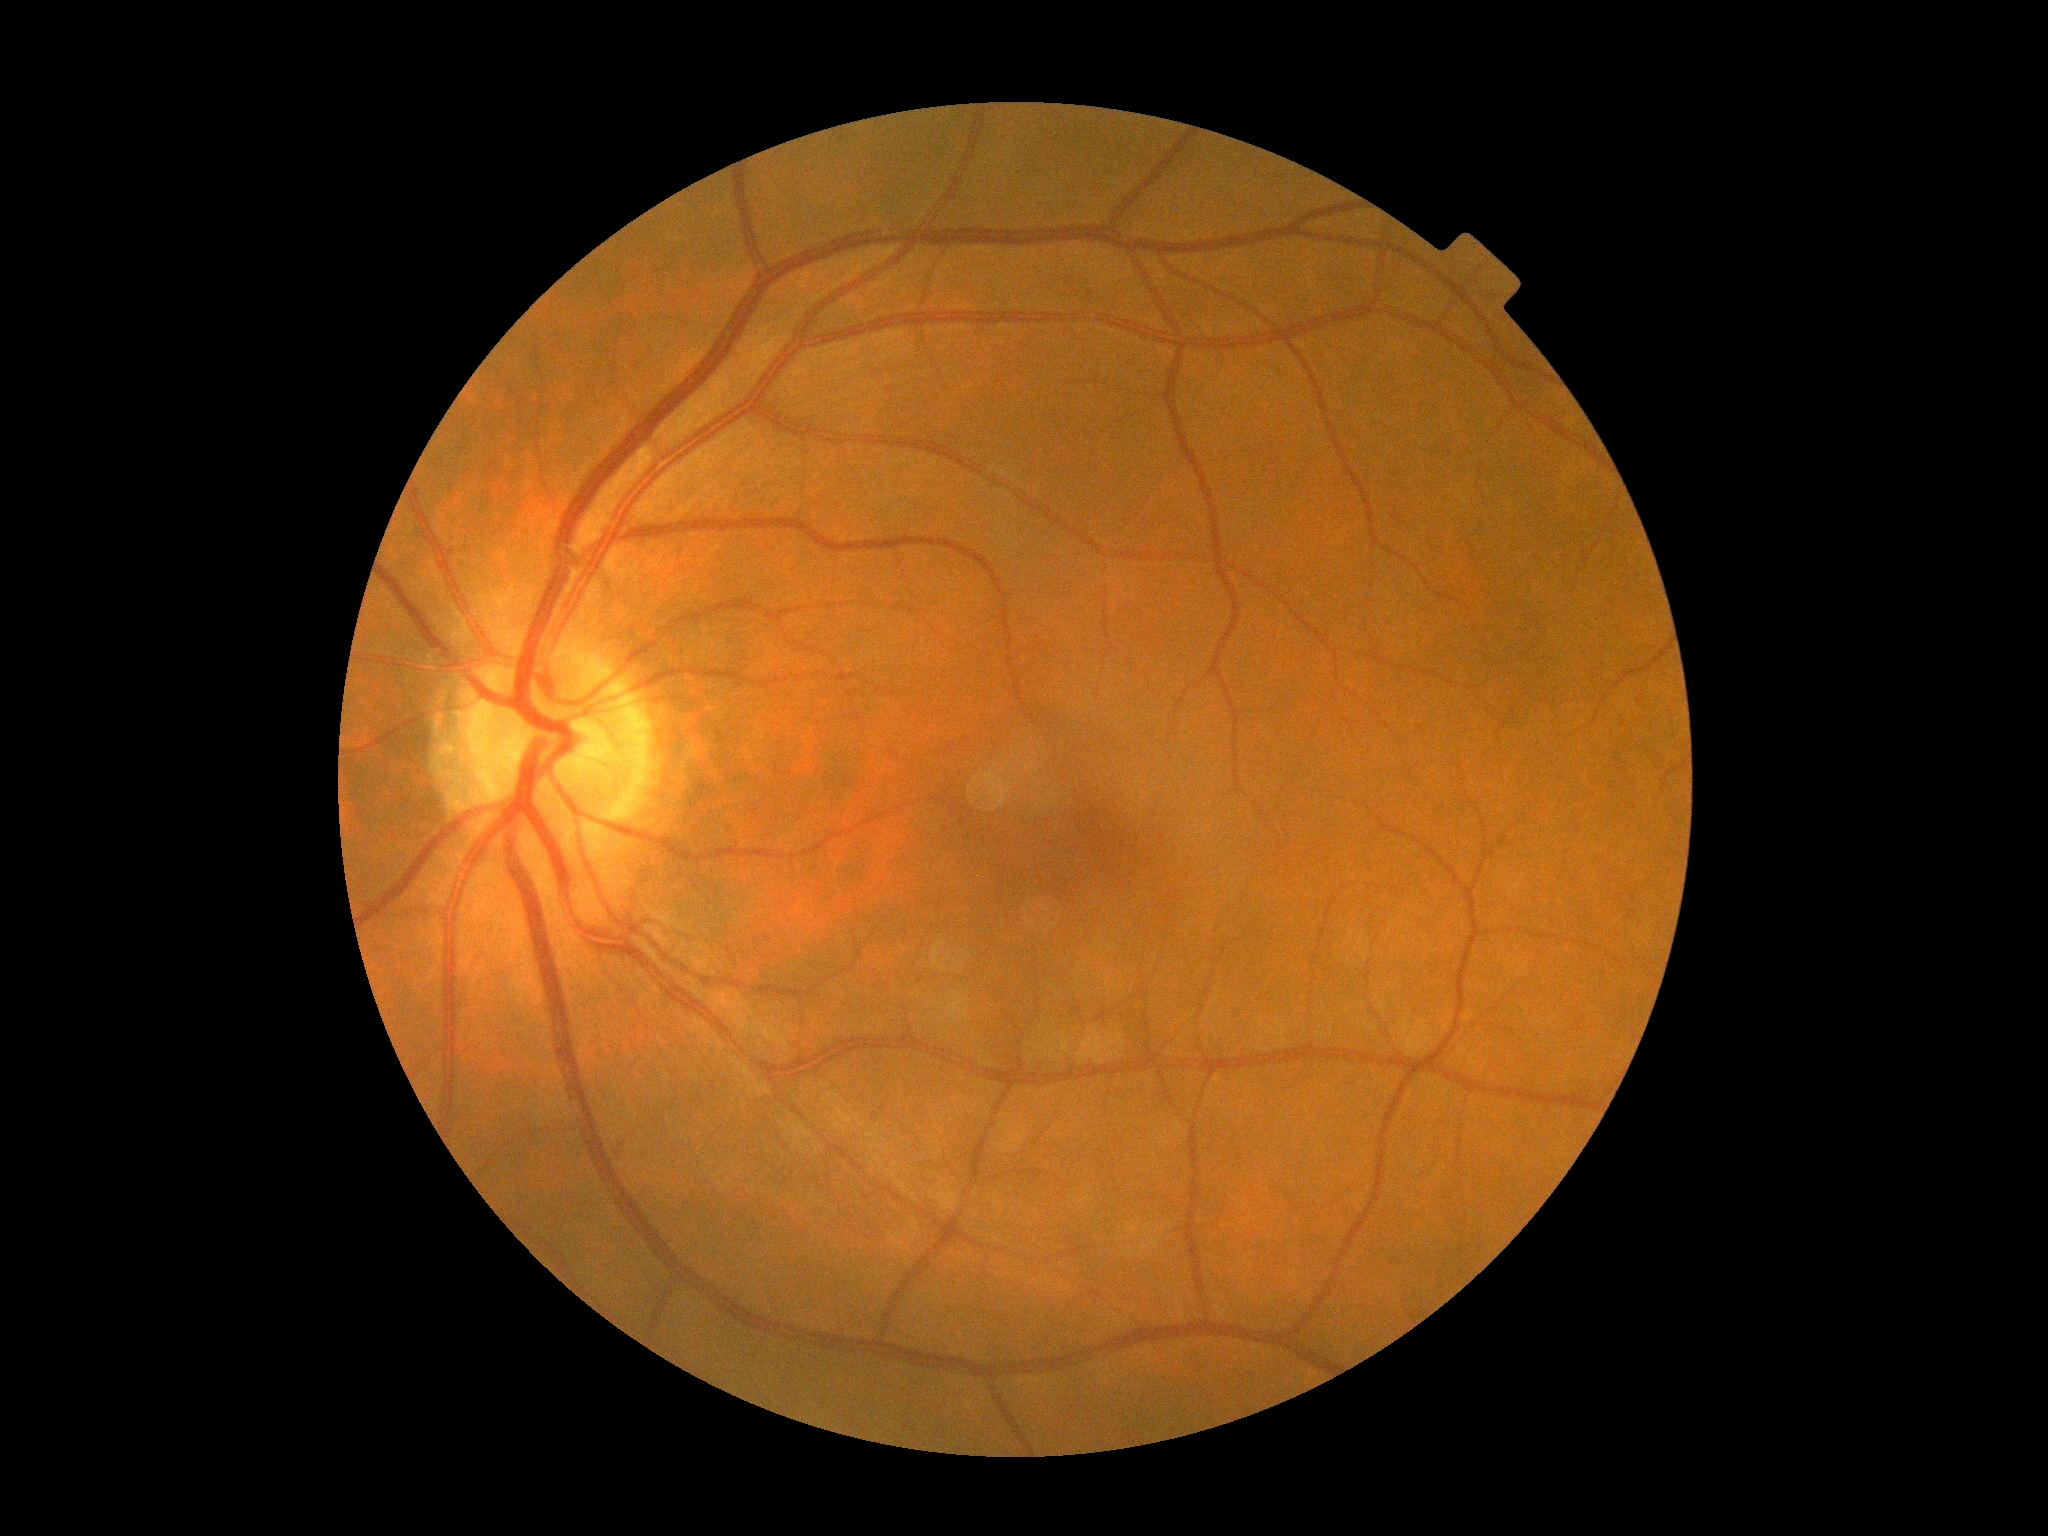

DR severity is 0/4.